CFP, 45° FOV, 2352x1568 — 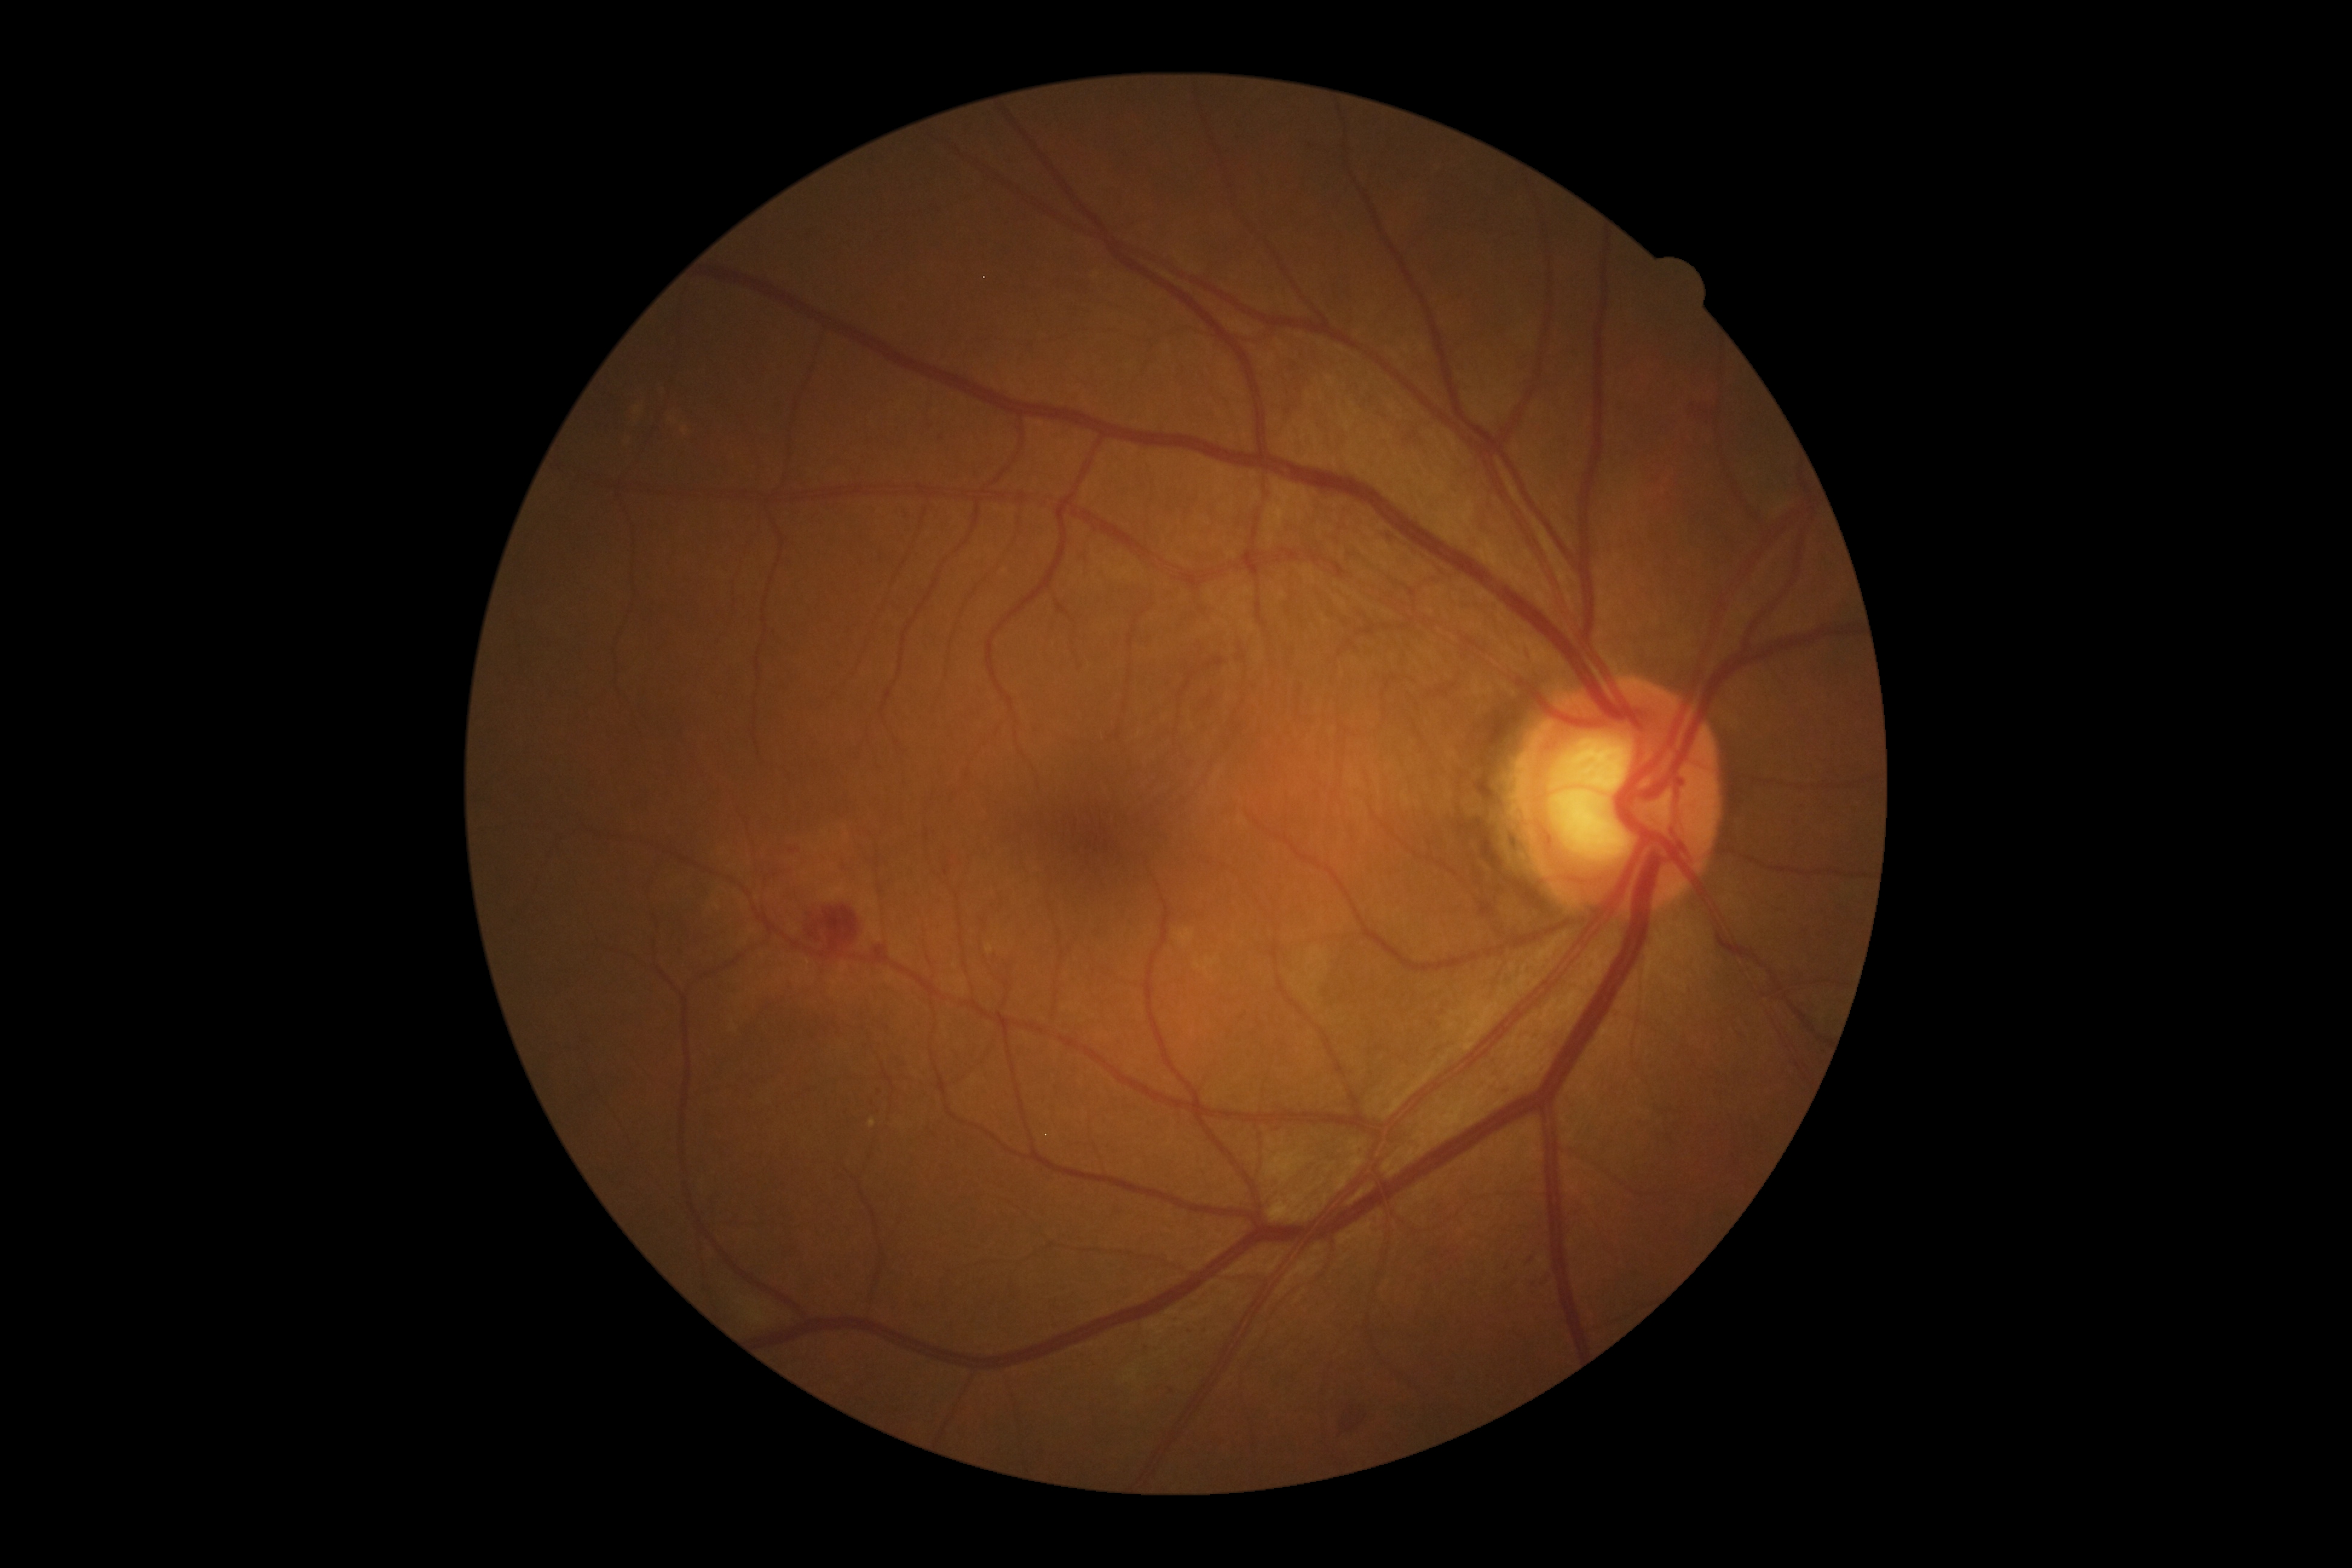

The retinopathy is classified as non-proliferative diabetic retinopathy. DR stage is grade 2.